2228 x 1652 pixels.
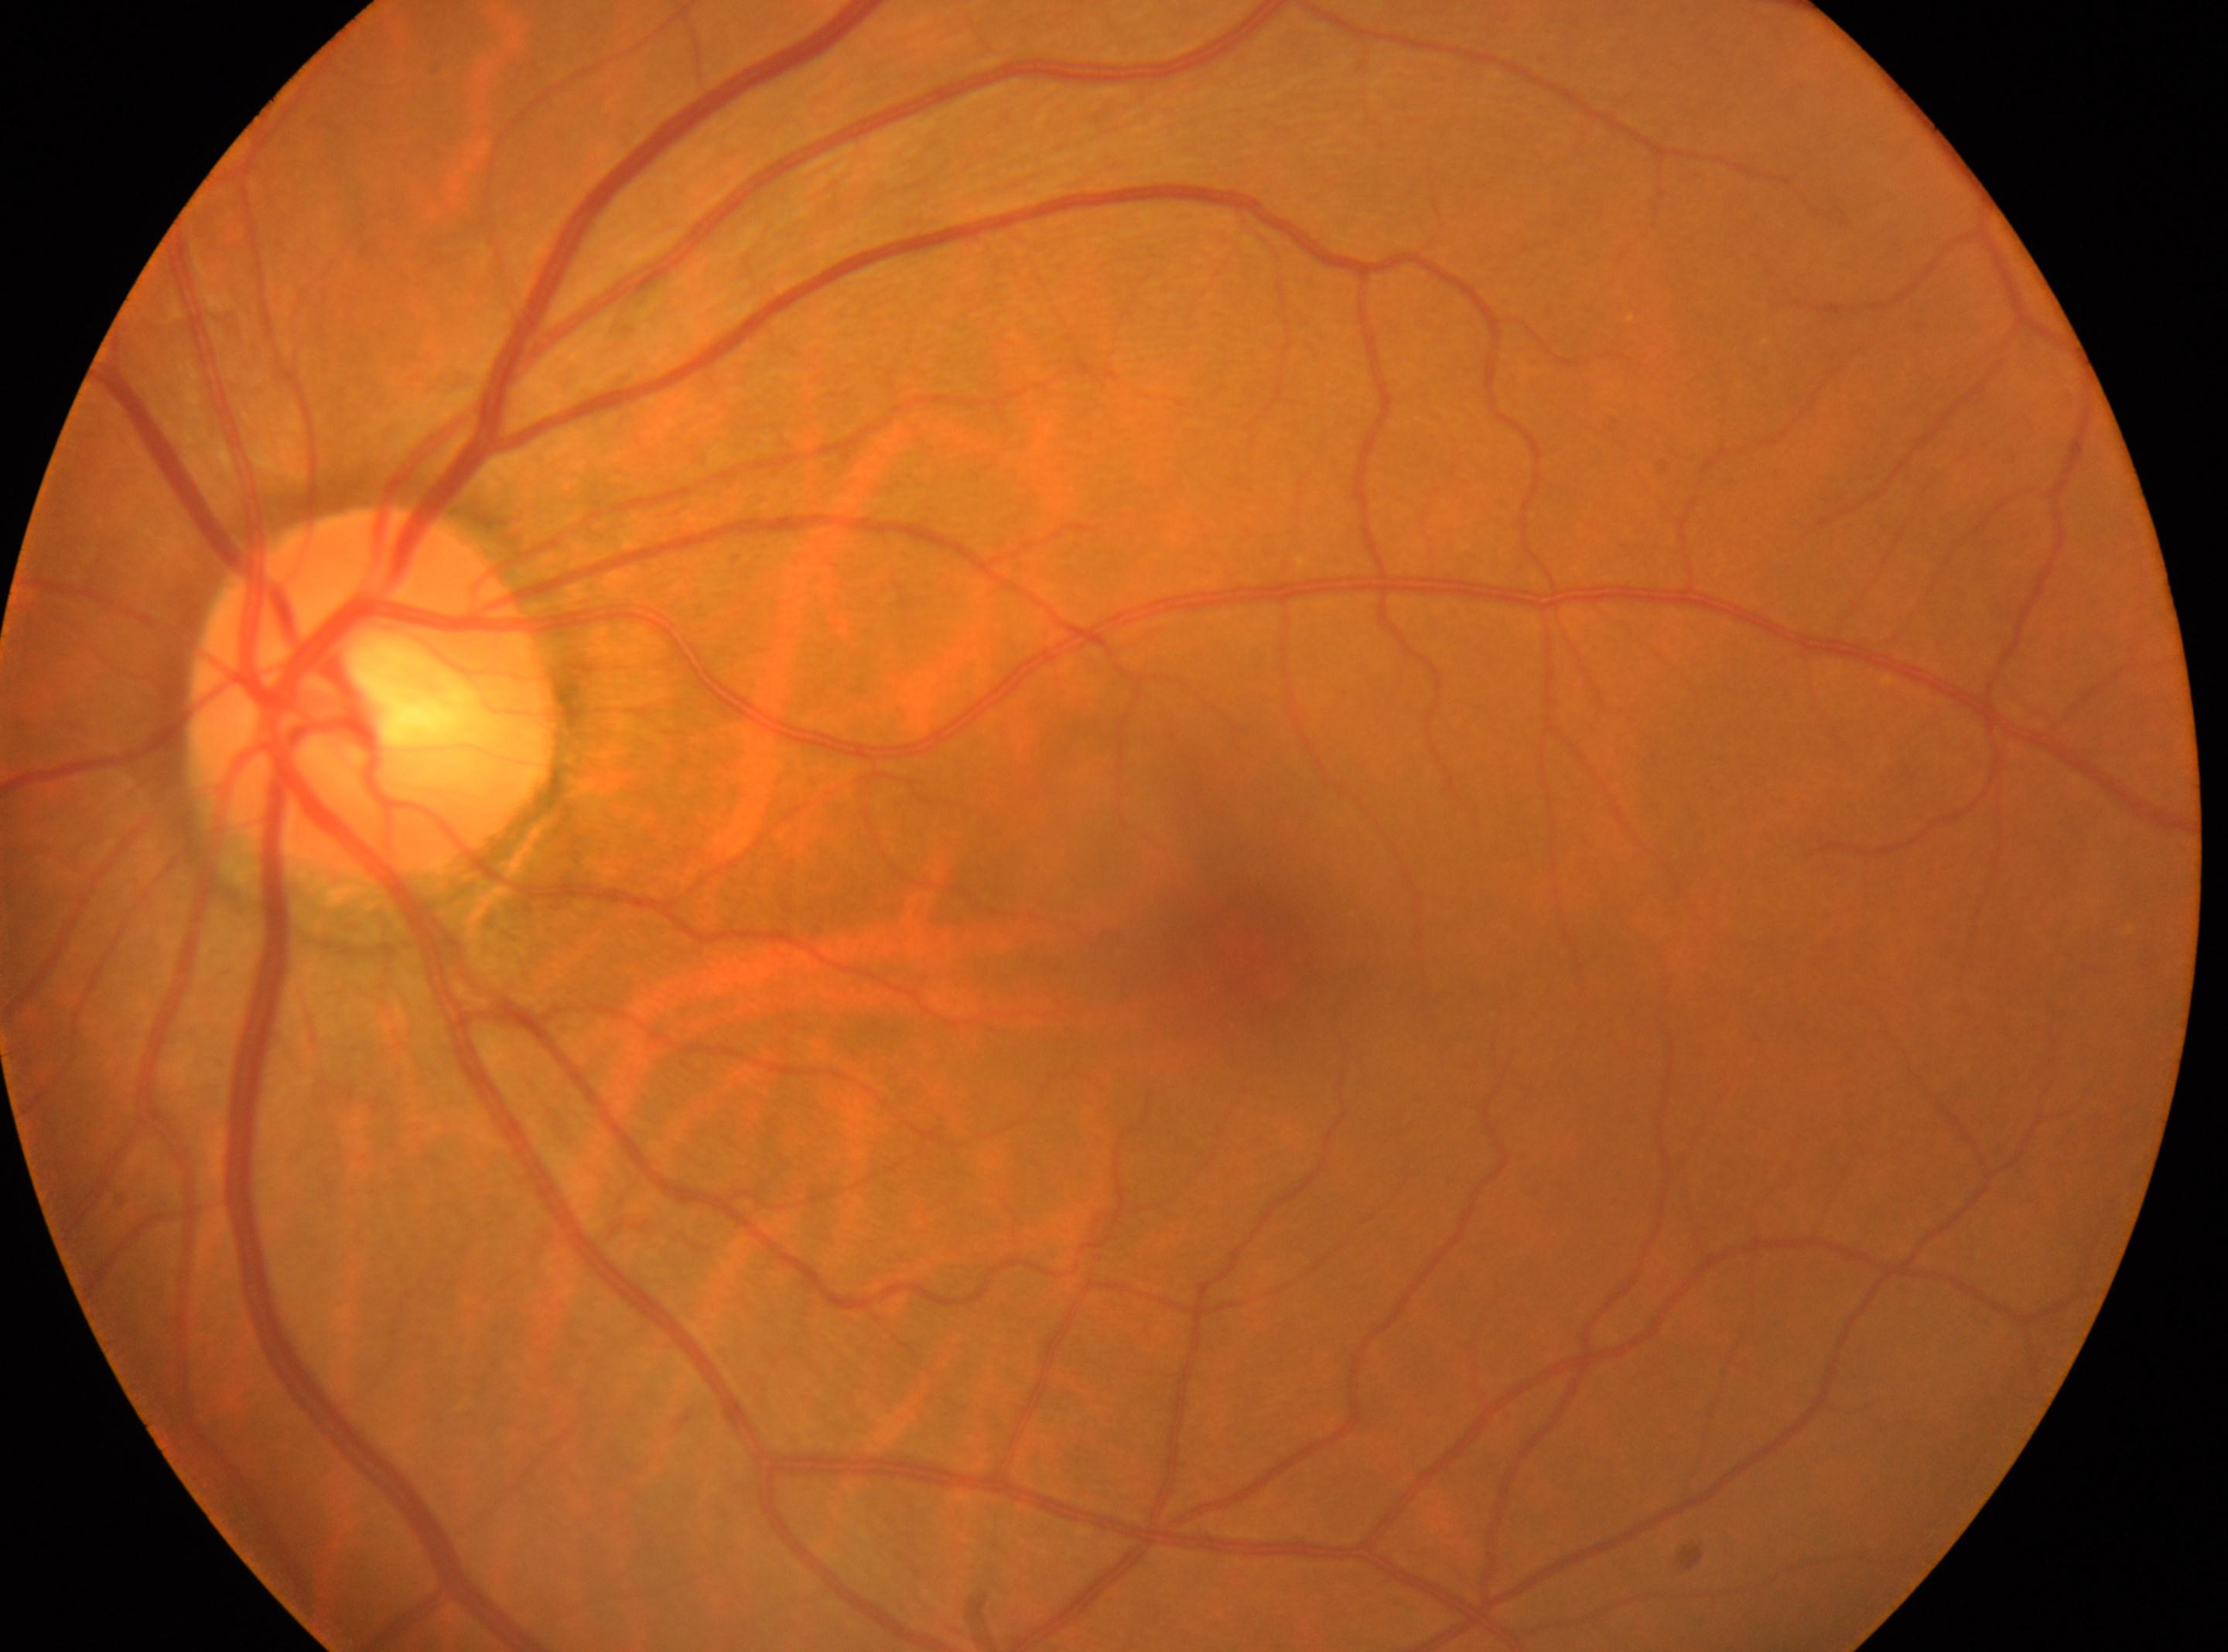

{
  "fovea": "[1255, 959]",
  "optic_disc": "[371, 696]",
  "eye": "oculus sinister",
  "dr_grade": "0/4"
}